Retinal fundus photograph · nonmydriatic fundus photograph · modified Davis grading:
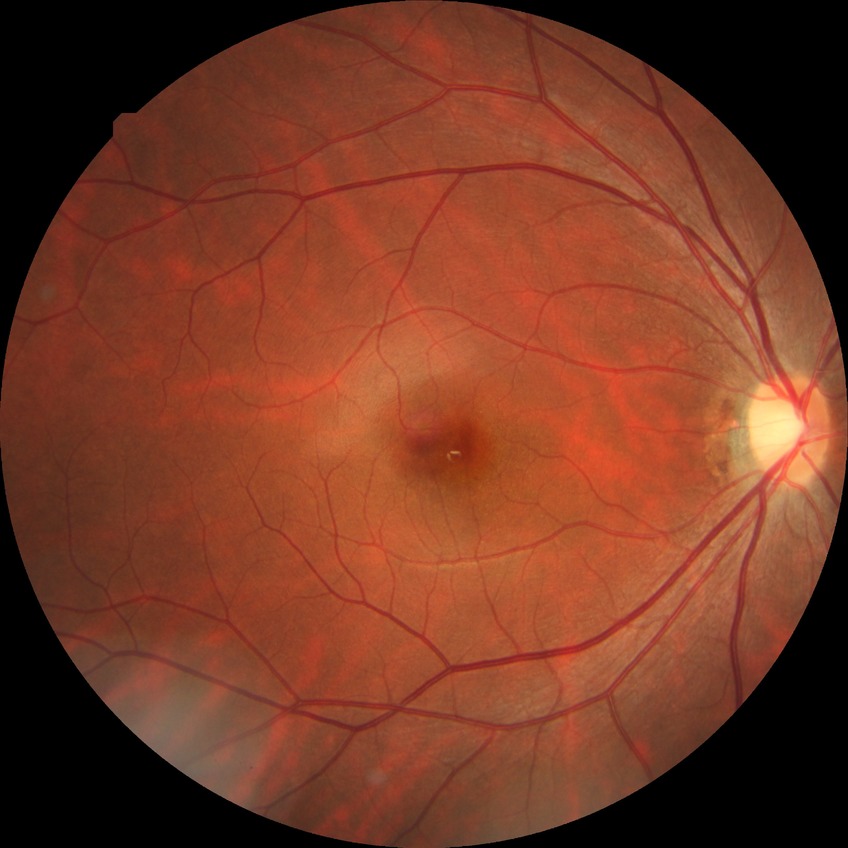
Findings:
• diabetic retinopathy grade: no diabetic retinopathy